45° field of view; graded on the modified Davis scale; camera: NIDEK AFC-230:
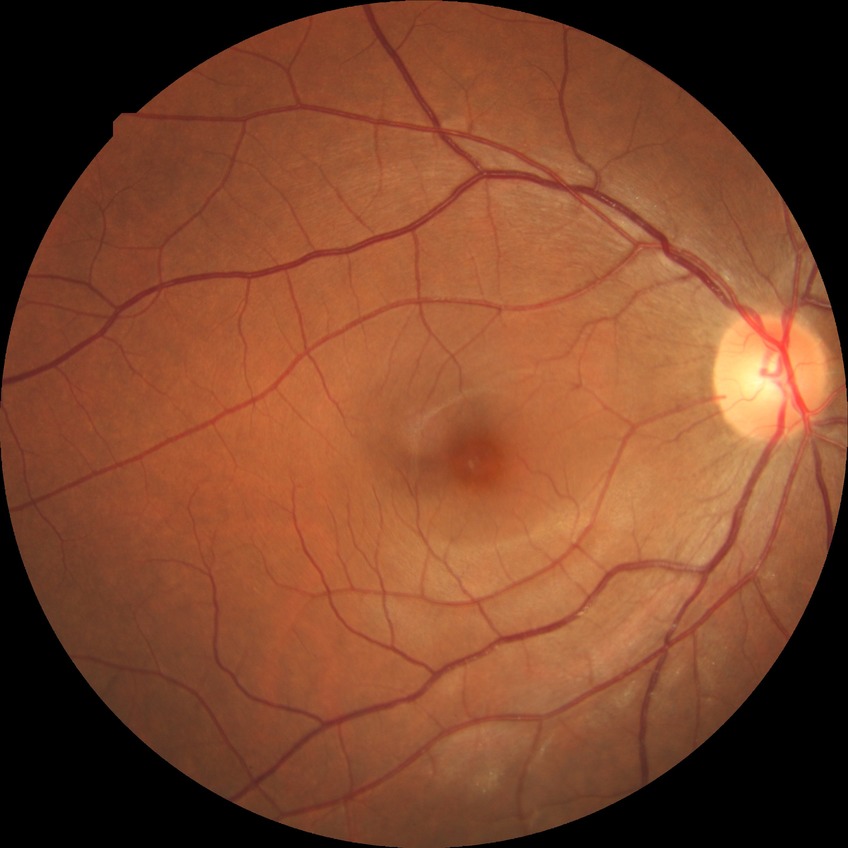 Diabetic retinopathy (DR): no diabetic retinopathy (NDR).